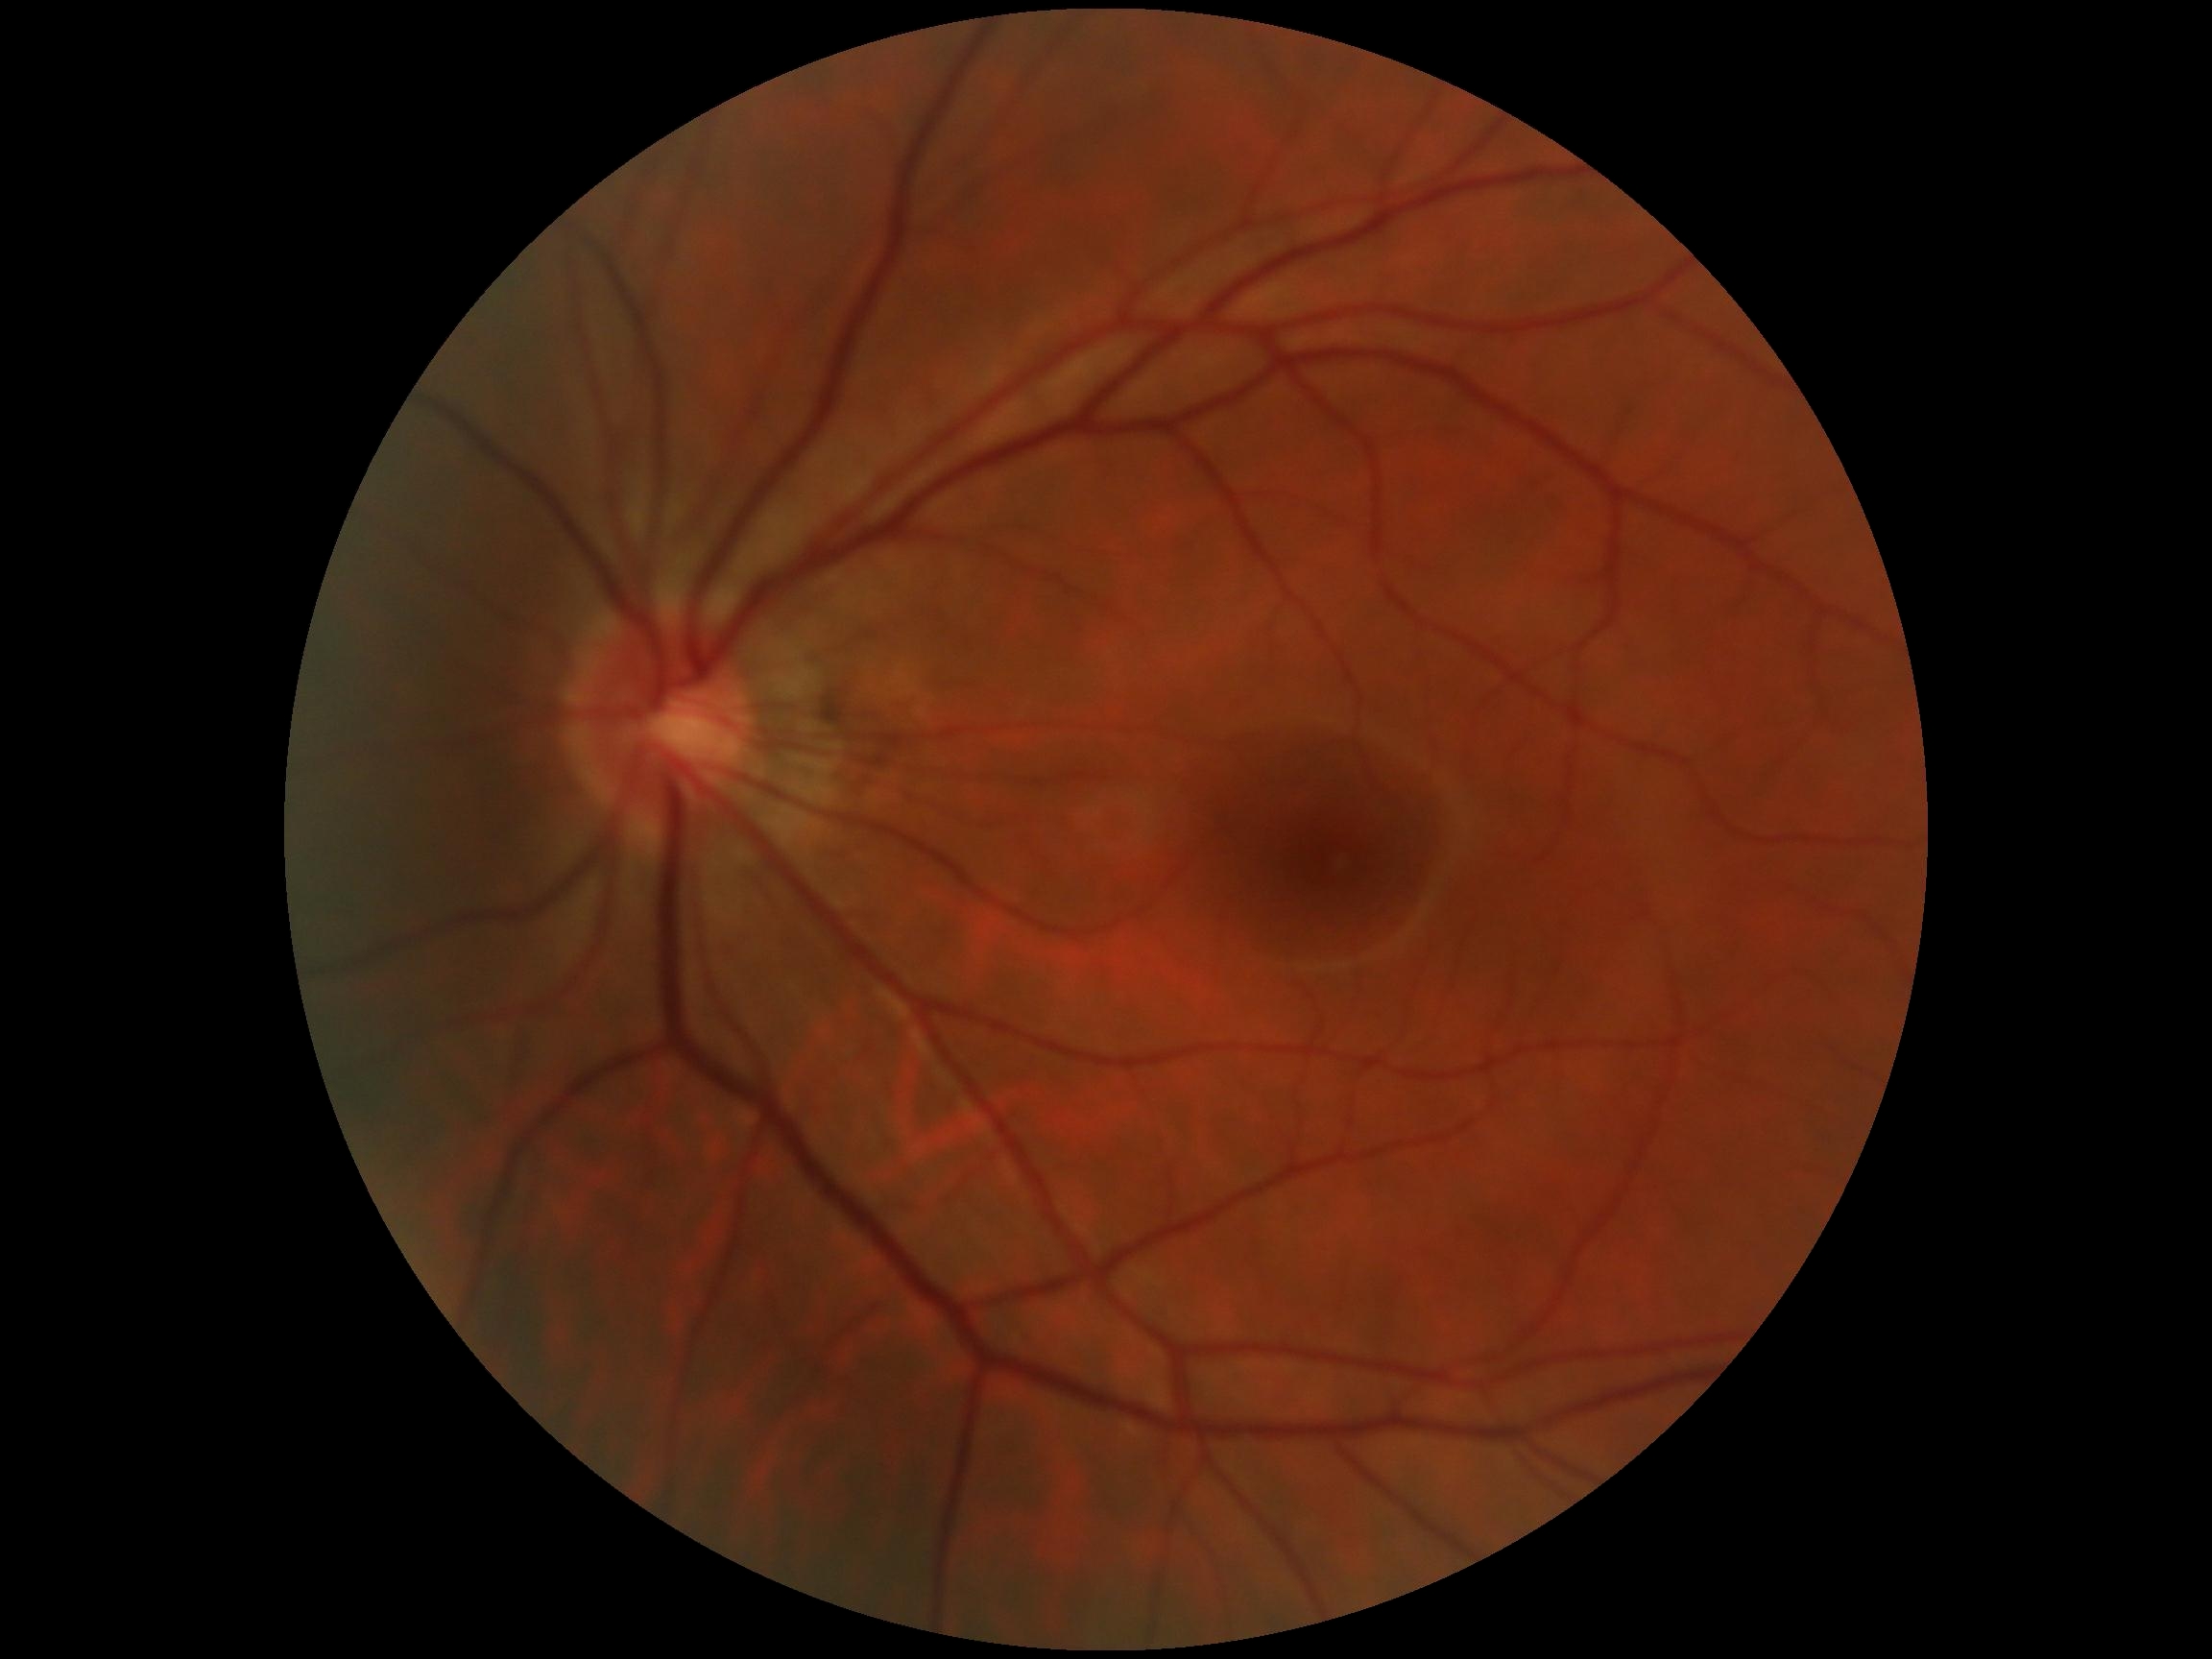 Diabetic retinopathy: grade 0 (no apparent retinopathy).